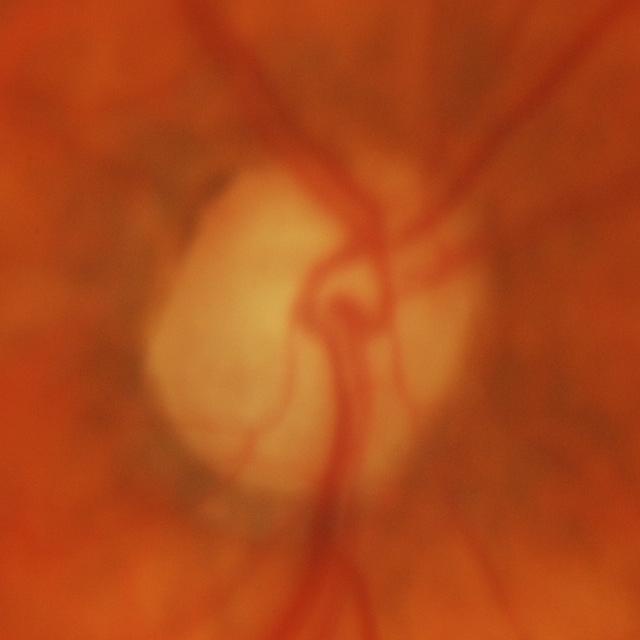

Glaucomatous changes.